45° field of view. Without pupil dilation
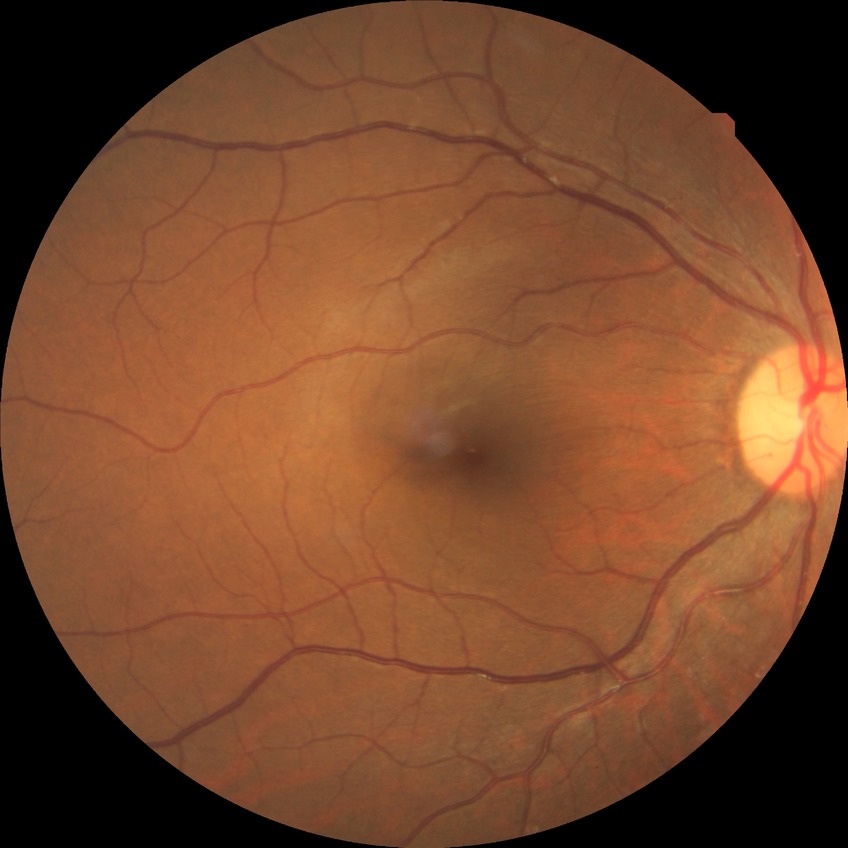
Diabetic retinopathy (DR): NDR (no diabetic retinopathy).